Infant wide-field retinal image — 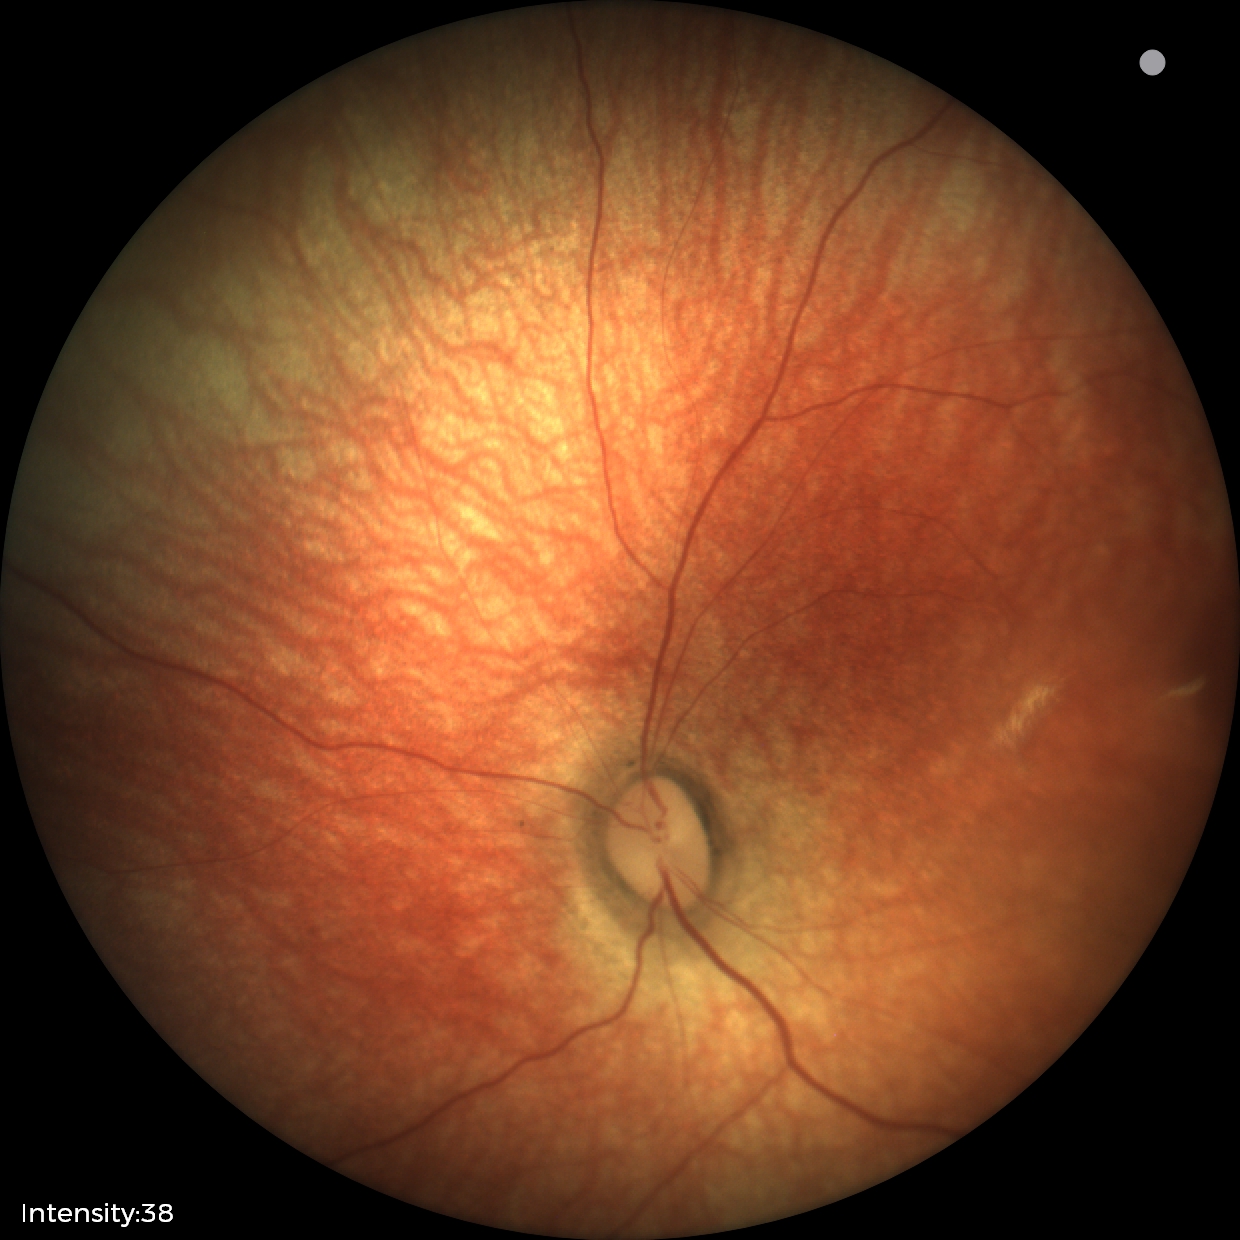

Screening examination diagnosed as physiological.